Modified Davis grading — 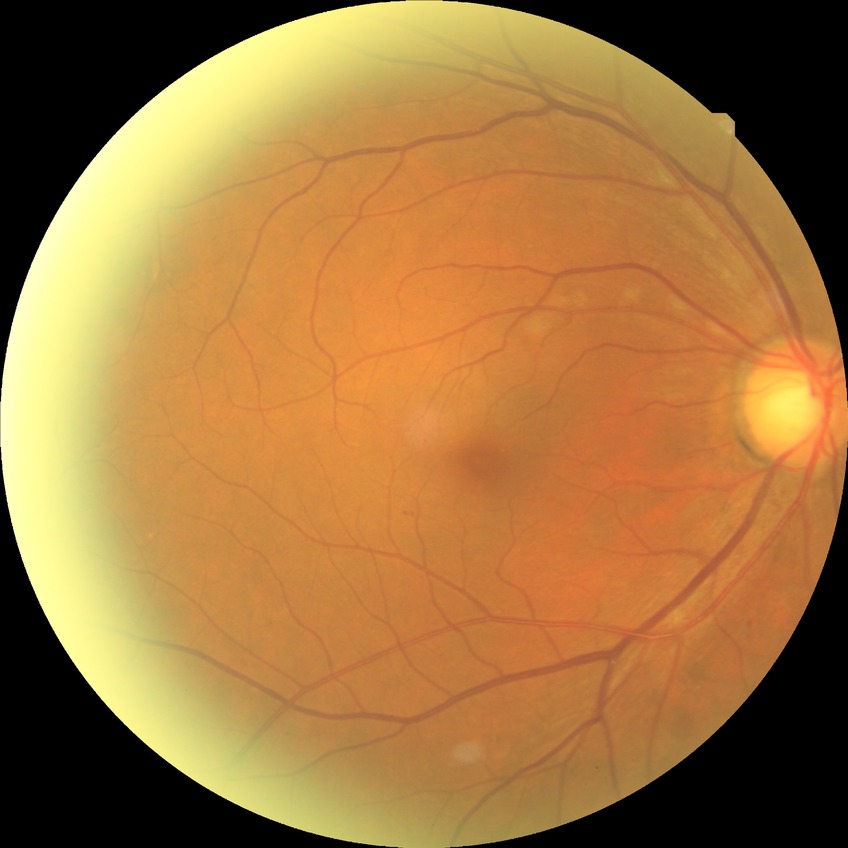
{
  "davis_grade": "NDR (no diabetic retinopathy)"
}